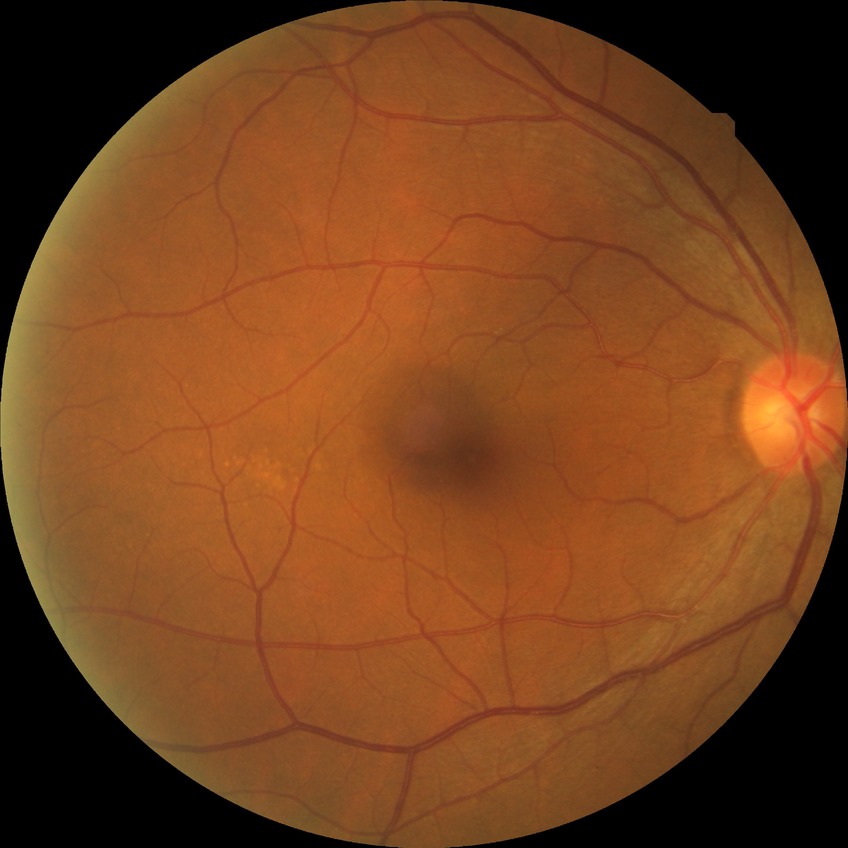

  davis_grade: no diabetic retinopathy